CFP. 45° field of view
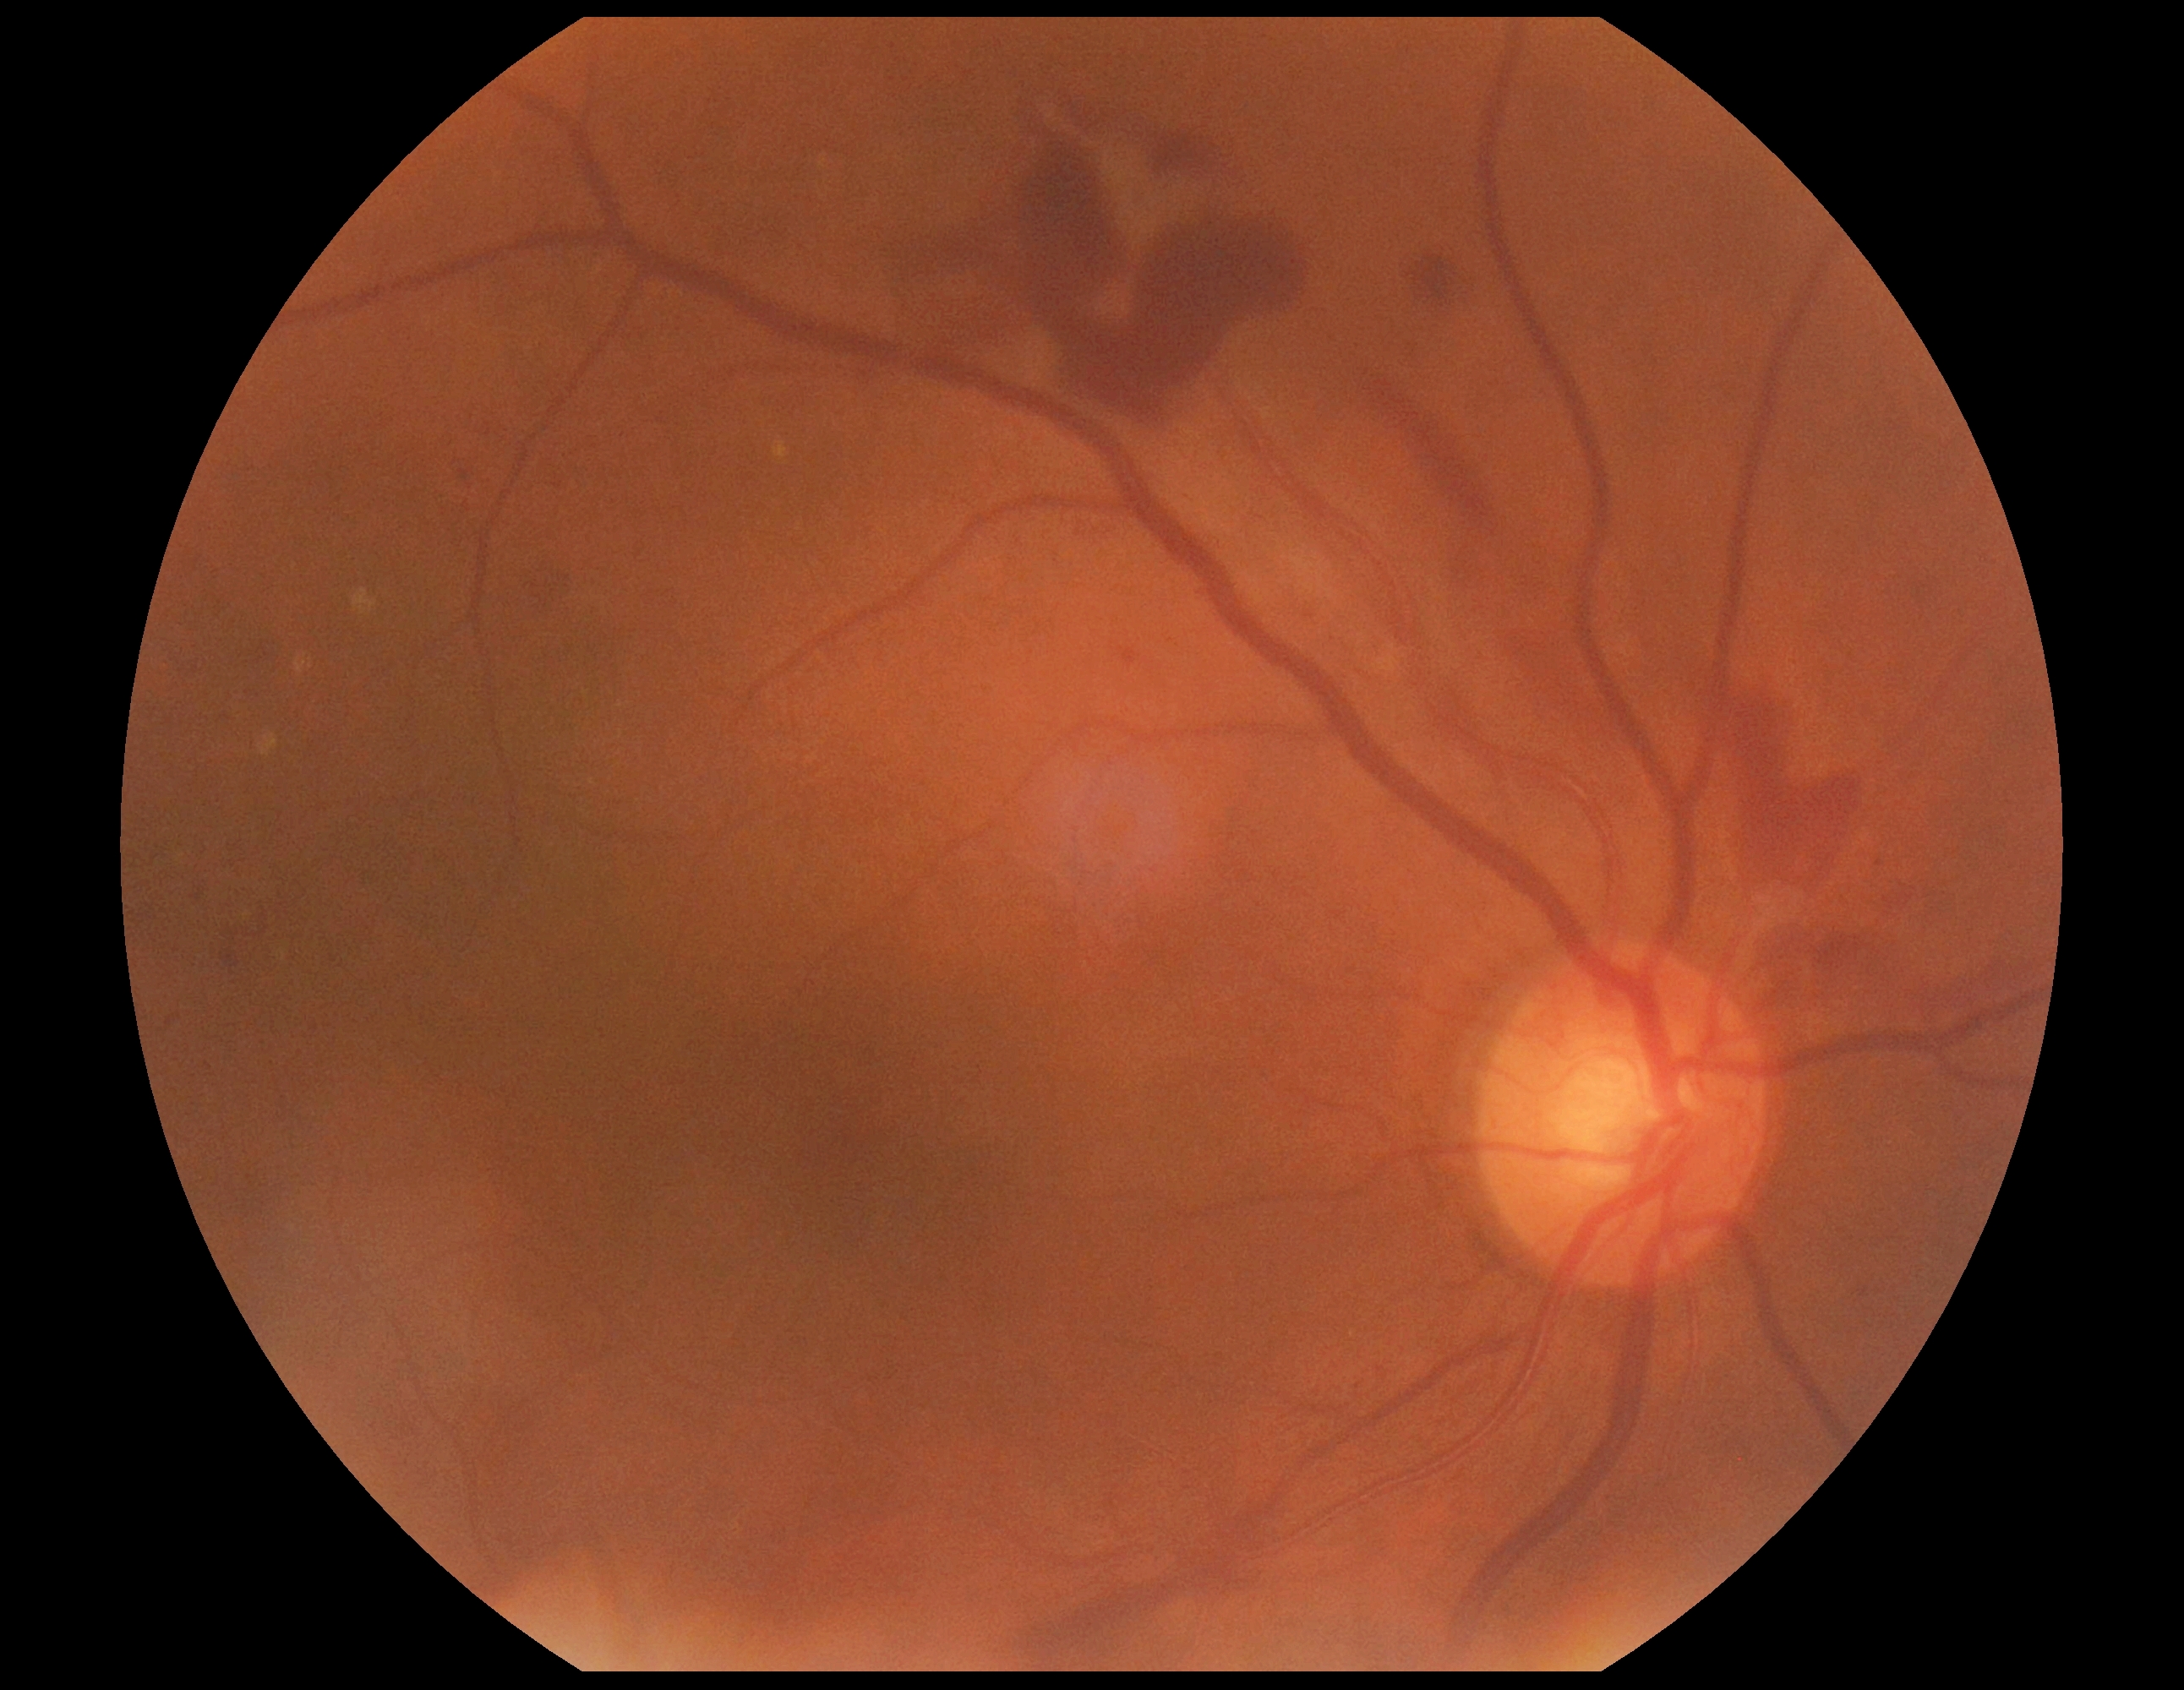

DR severity is grade 4 (PDR).